No pharmacologic dilation, acquired with a NIDEK AFC-230: 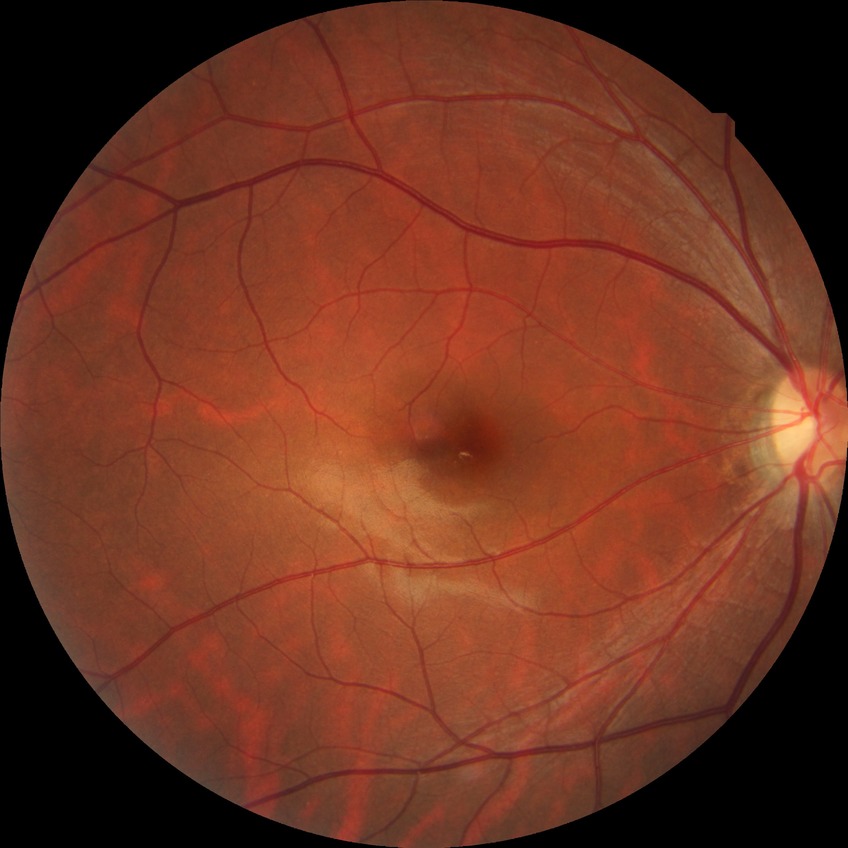
Diabetic retinopathy (DR): no diabetic retinopathy (NDR).